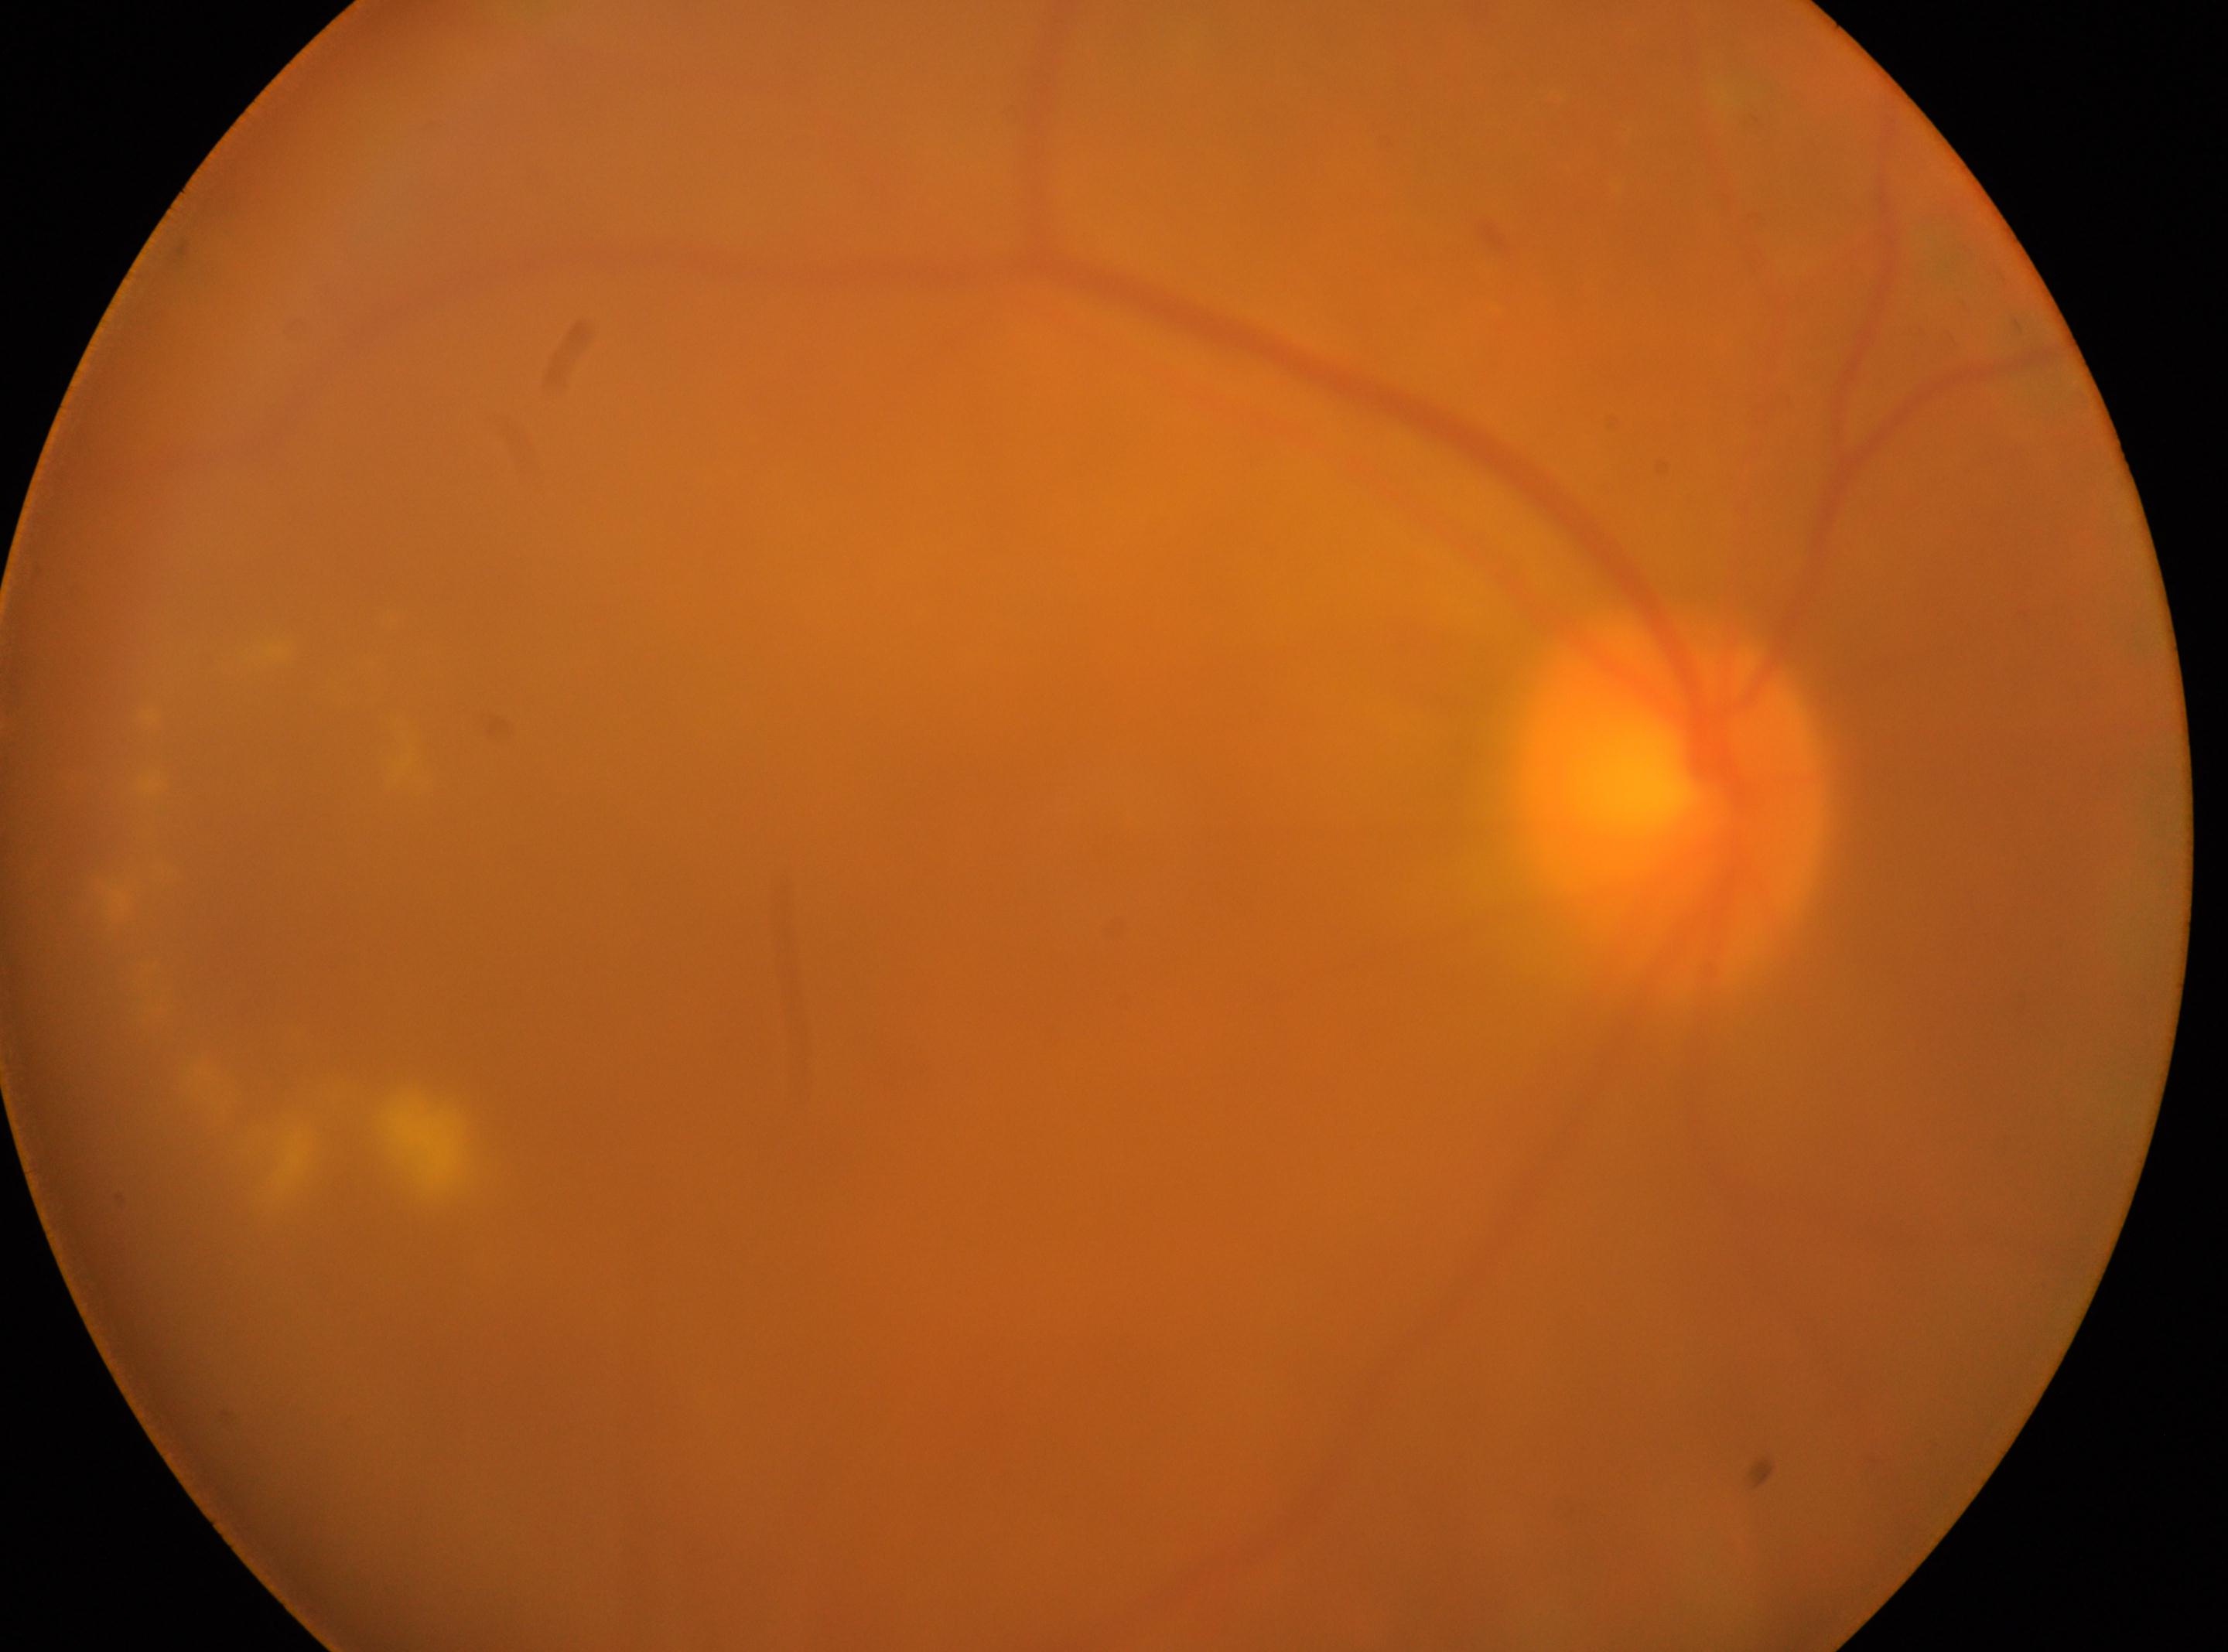
| field | value |
|---|---|
| diabetic retinopathy severity | 2/4 — more than just microaneurysms but less than severe NPDR |
| optic disc center | (1673,801) |
| the fovea | (854,1024) |
| eye | OD |